100° field of view (Phoenix ICON); pediatric retinal photograph (wide-field):
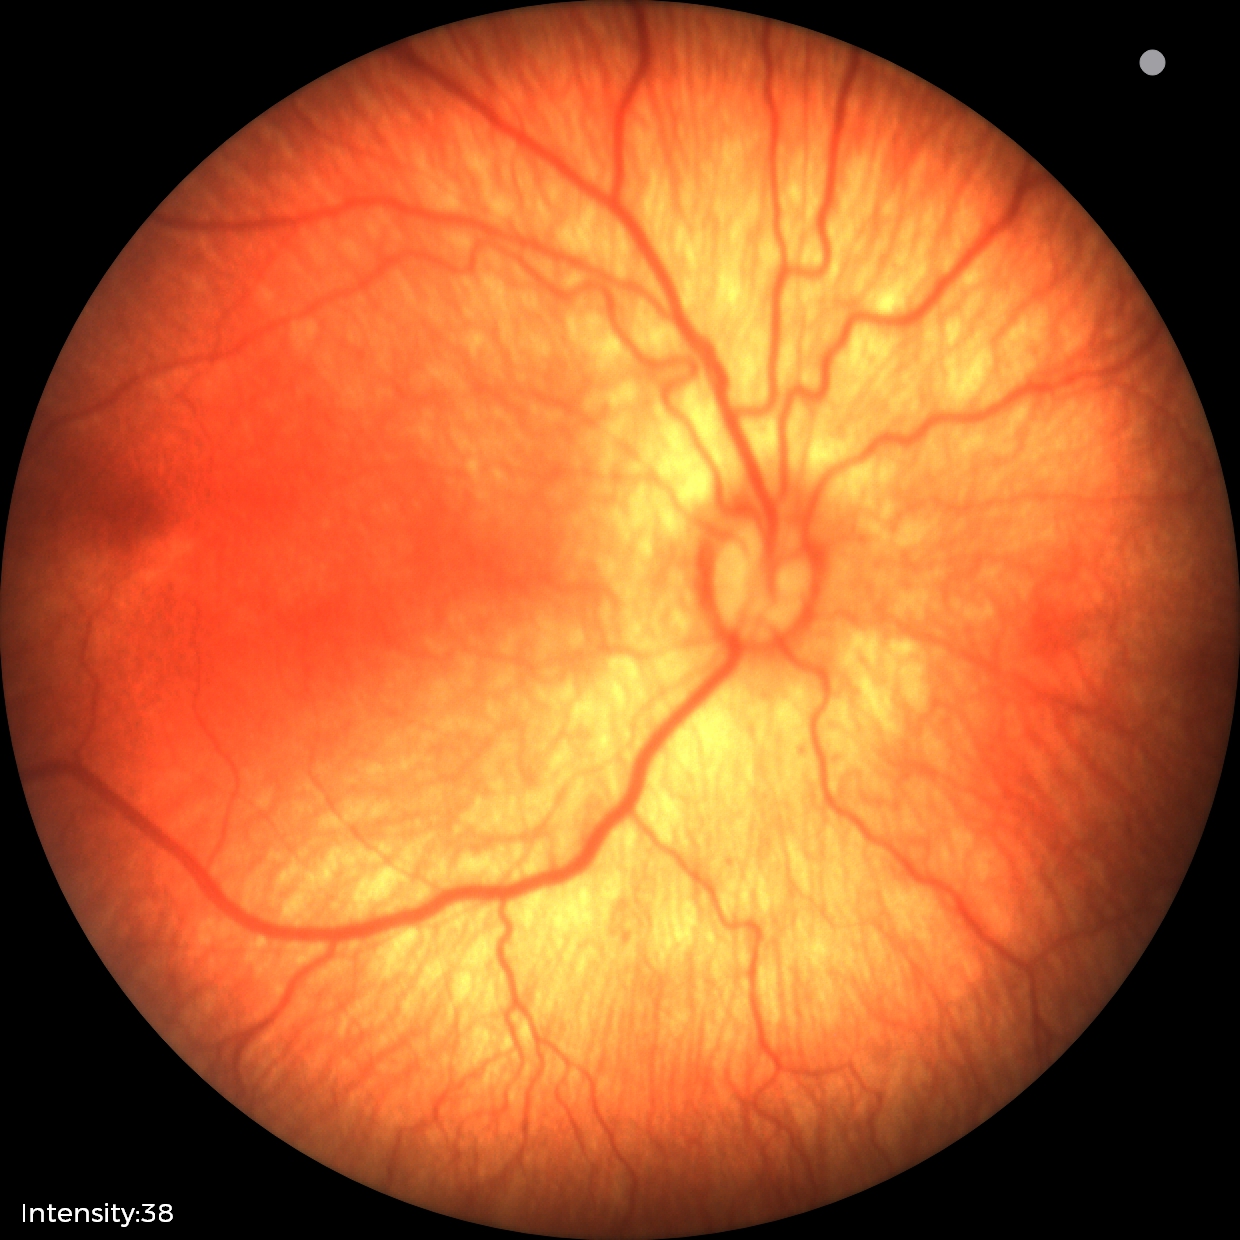

Q: What is the screening diagnosis?
A: status post retinopathy of prematurity (ROP)